Wide-field contact fundus photograph of an infant. Image size 1440x1080 — 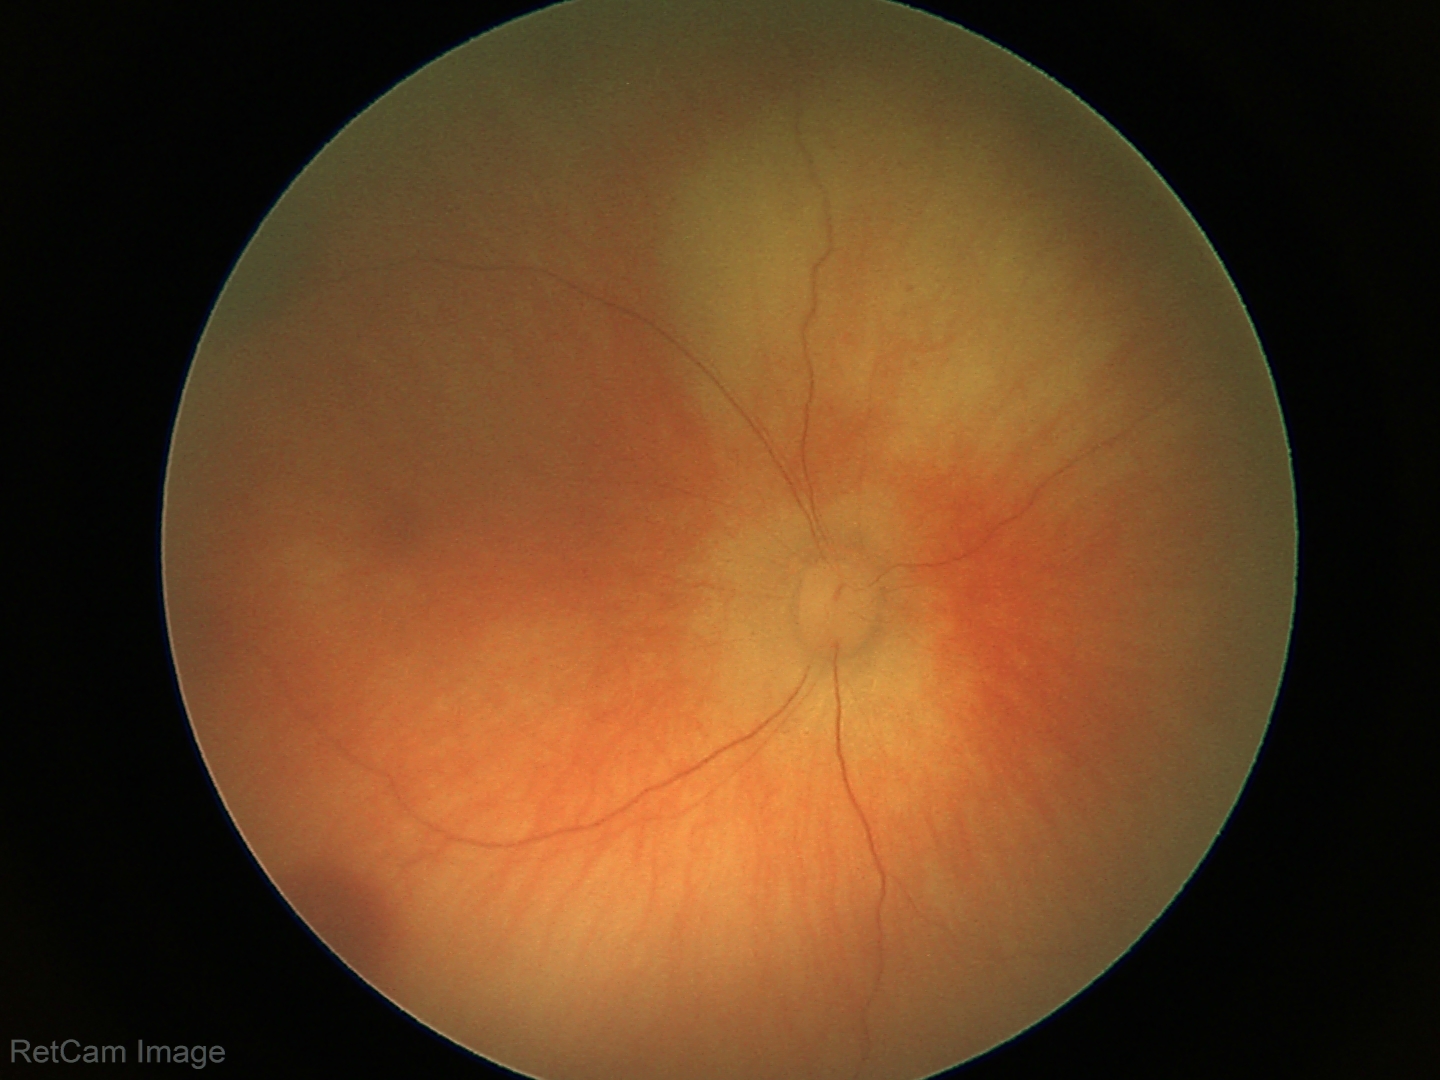

Q: What is the screening diagnosis?
A: retinal hemorrhages